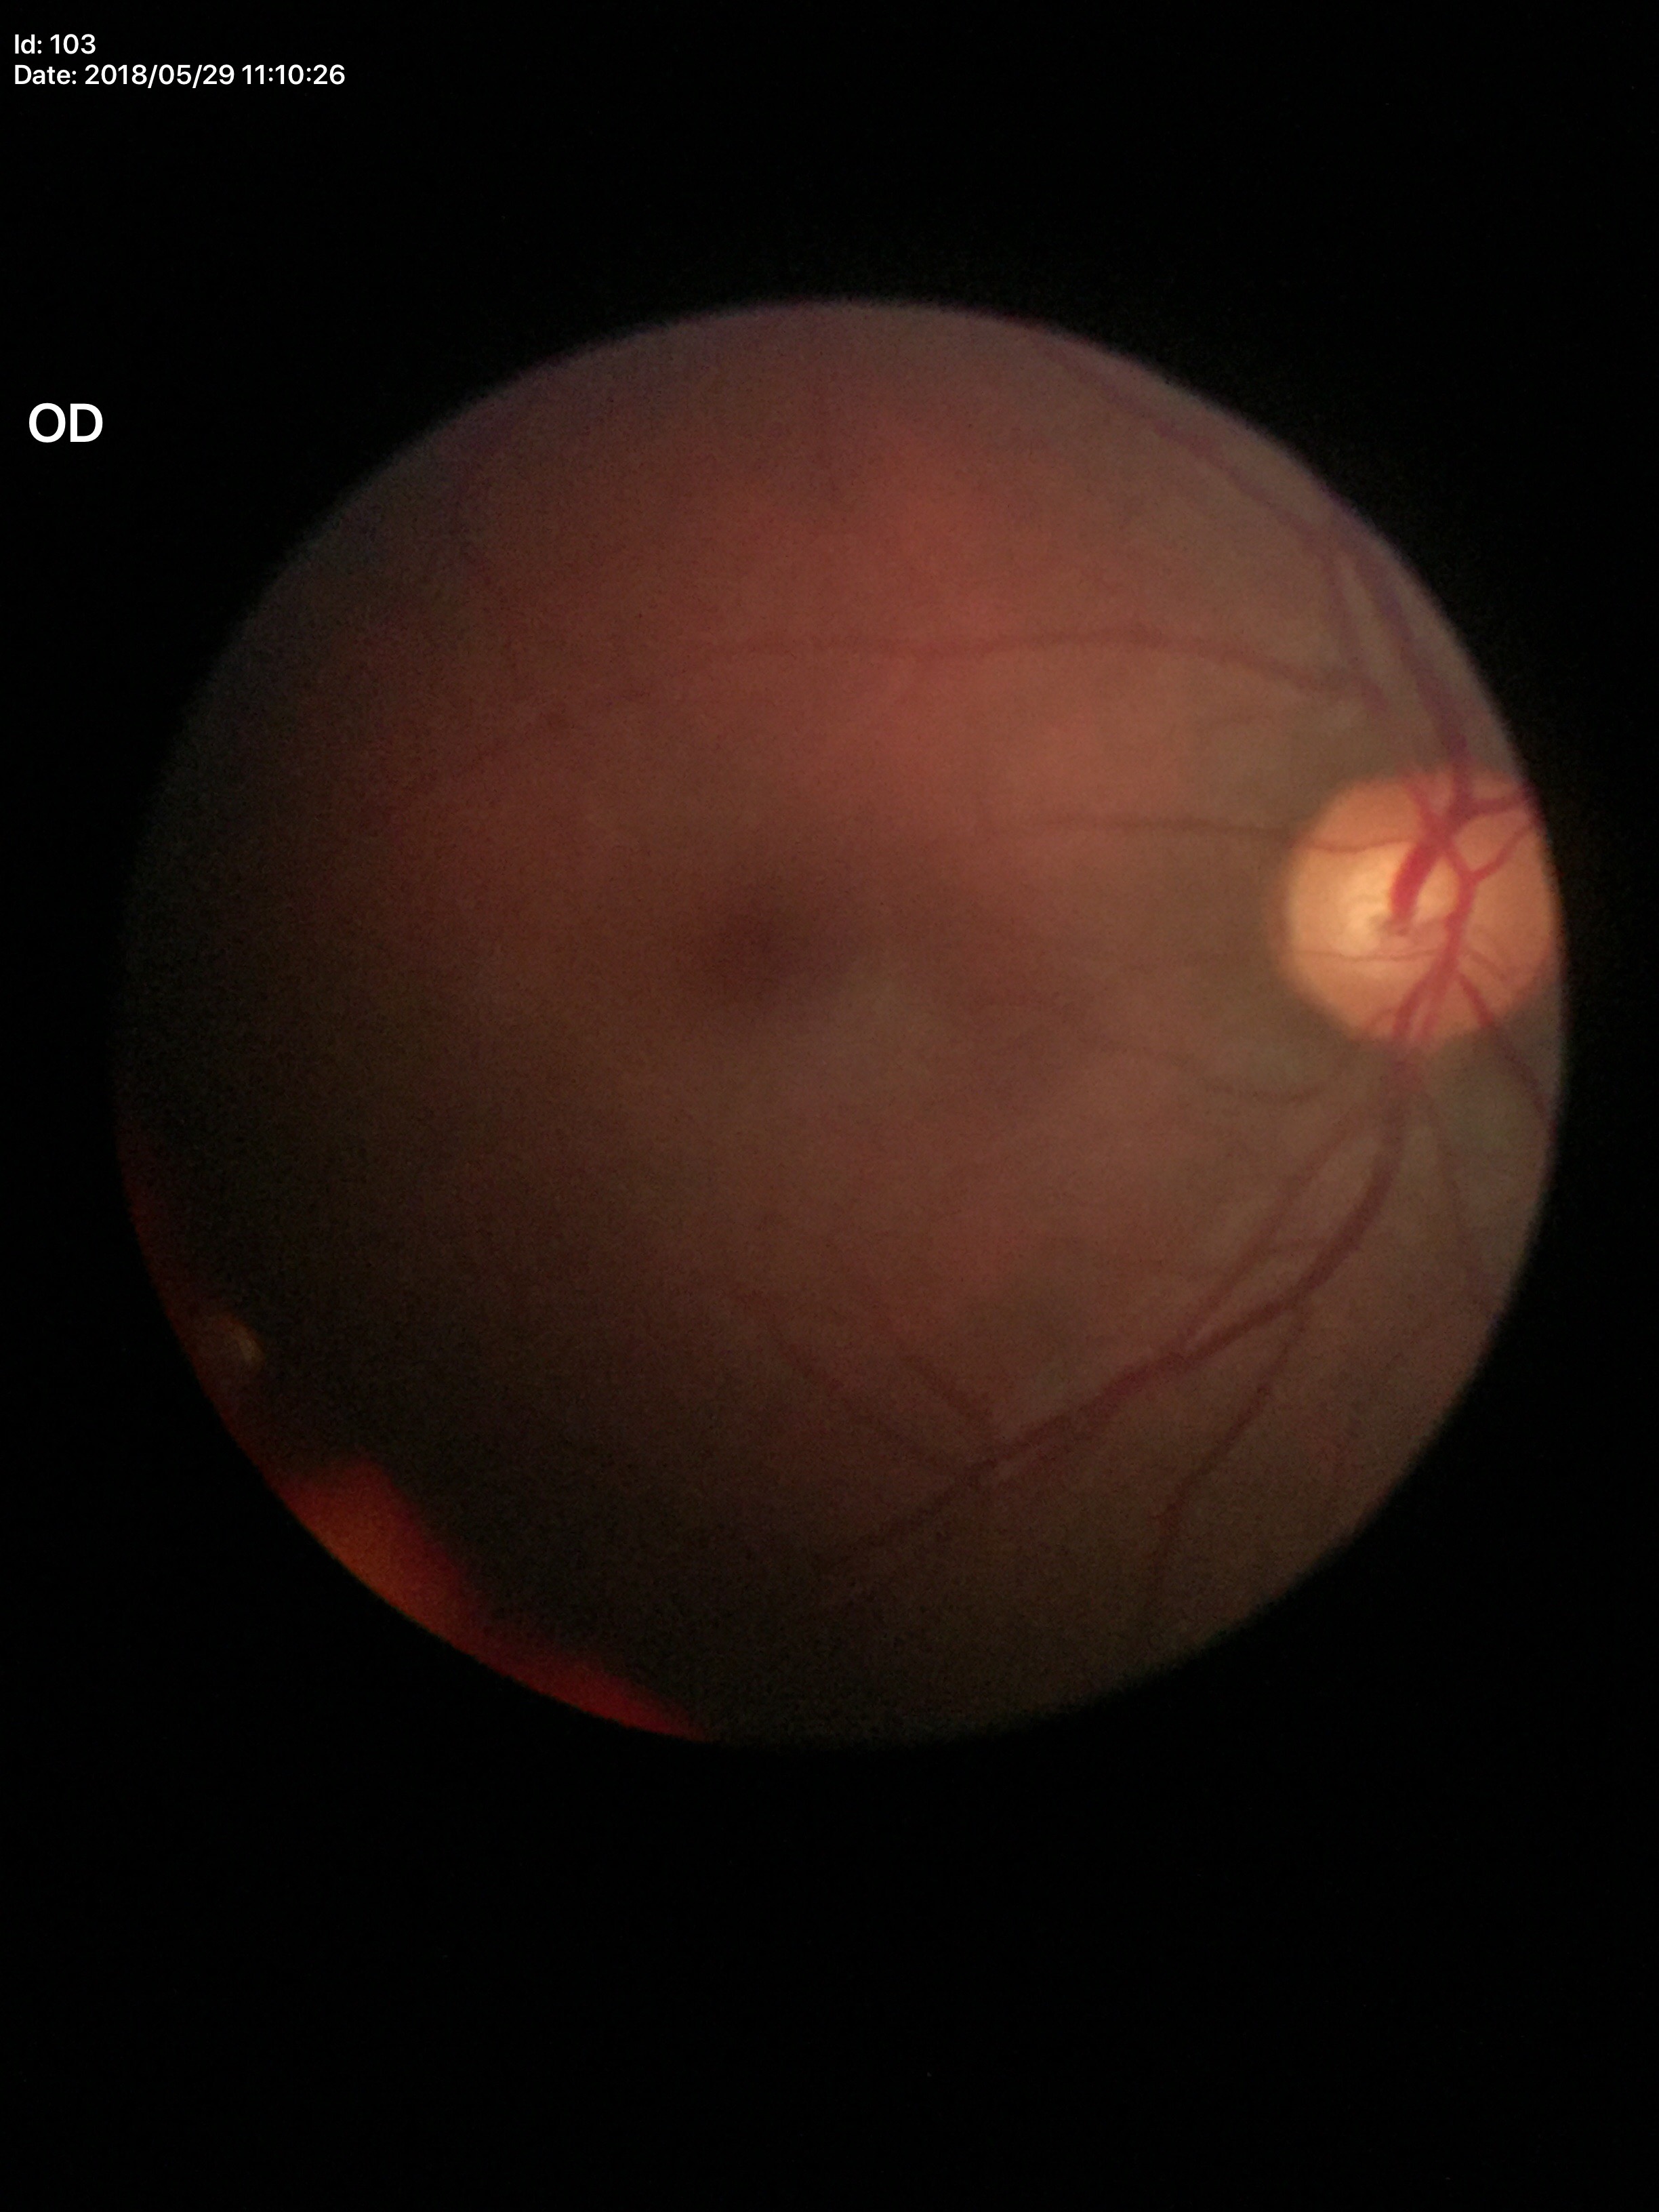

Glaucoma screening: no suspicious findings.
Vertical cup-to-disc ratio (VCDR): 0.54.
Horizontal cup-disc ratio (HCDR) is 0.56.